Camera: Clarity RetCam 3 (130° FOV) · pediatric wide-field fundus photograph:
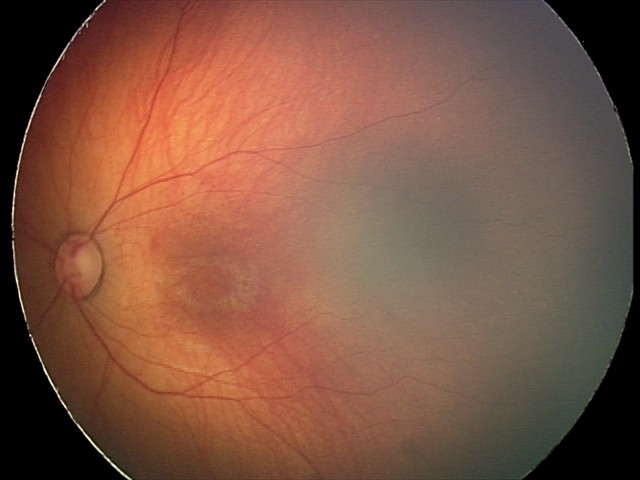
Series diagnosed as retinal hemorrhages.